NIDEK AFC-230 fundus camera — 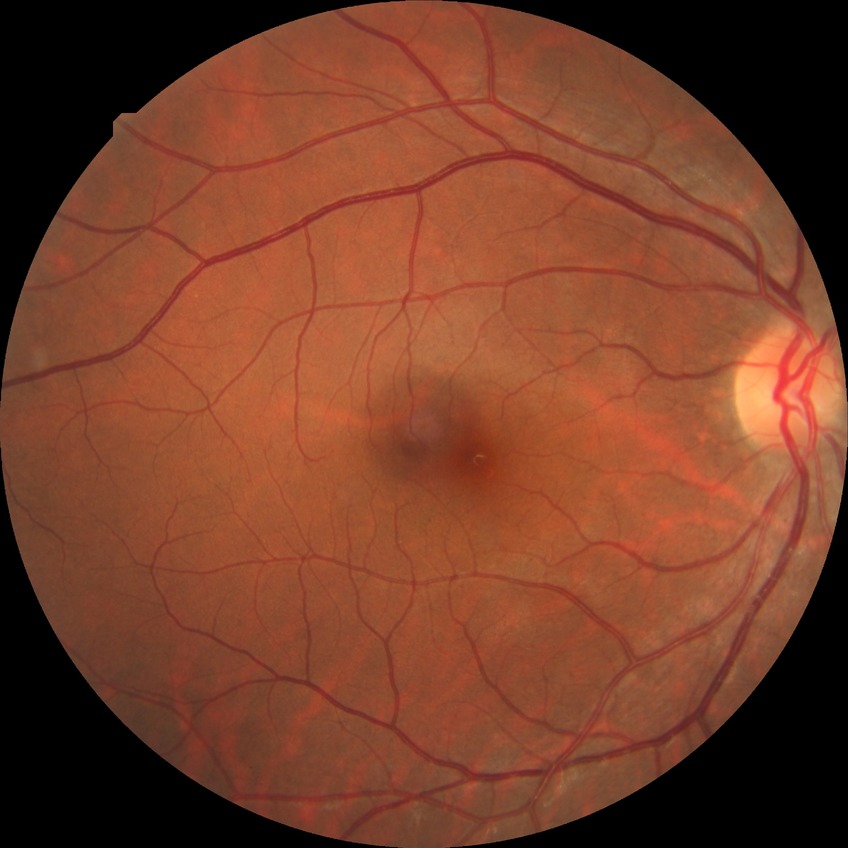
Modified Davis grading is no diabetic retinopathy.